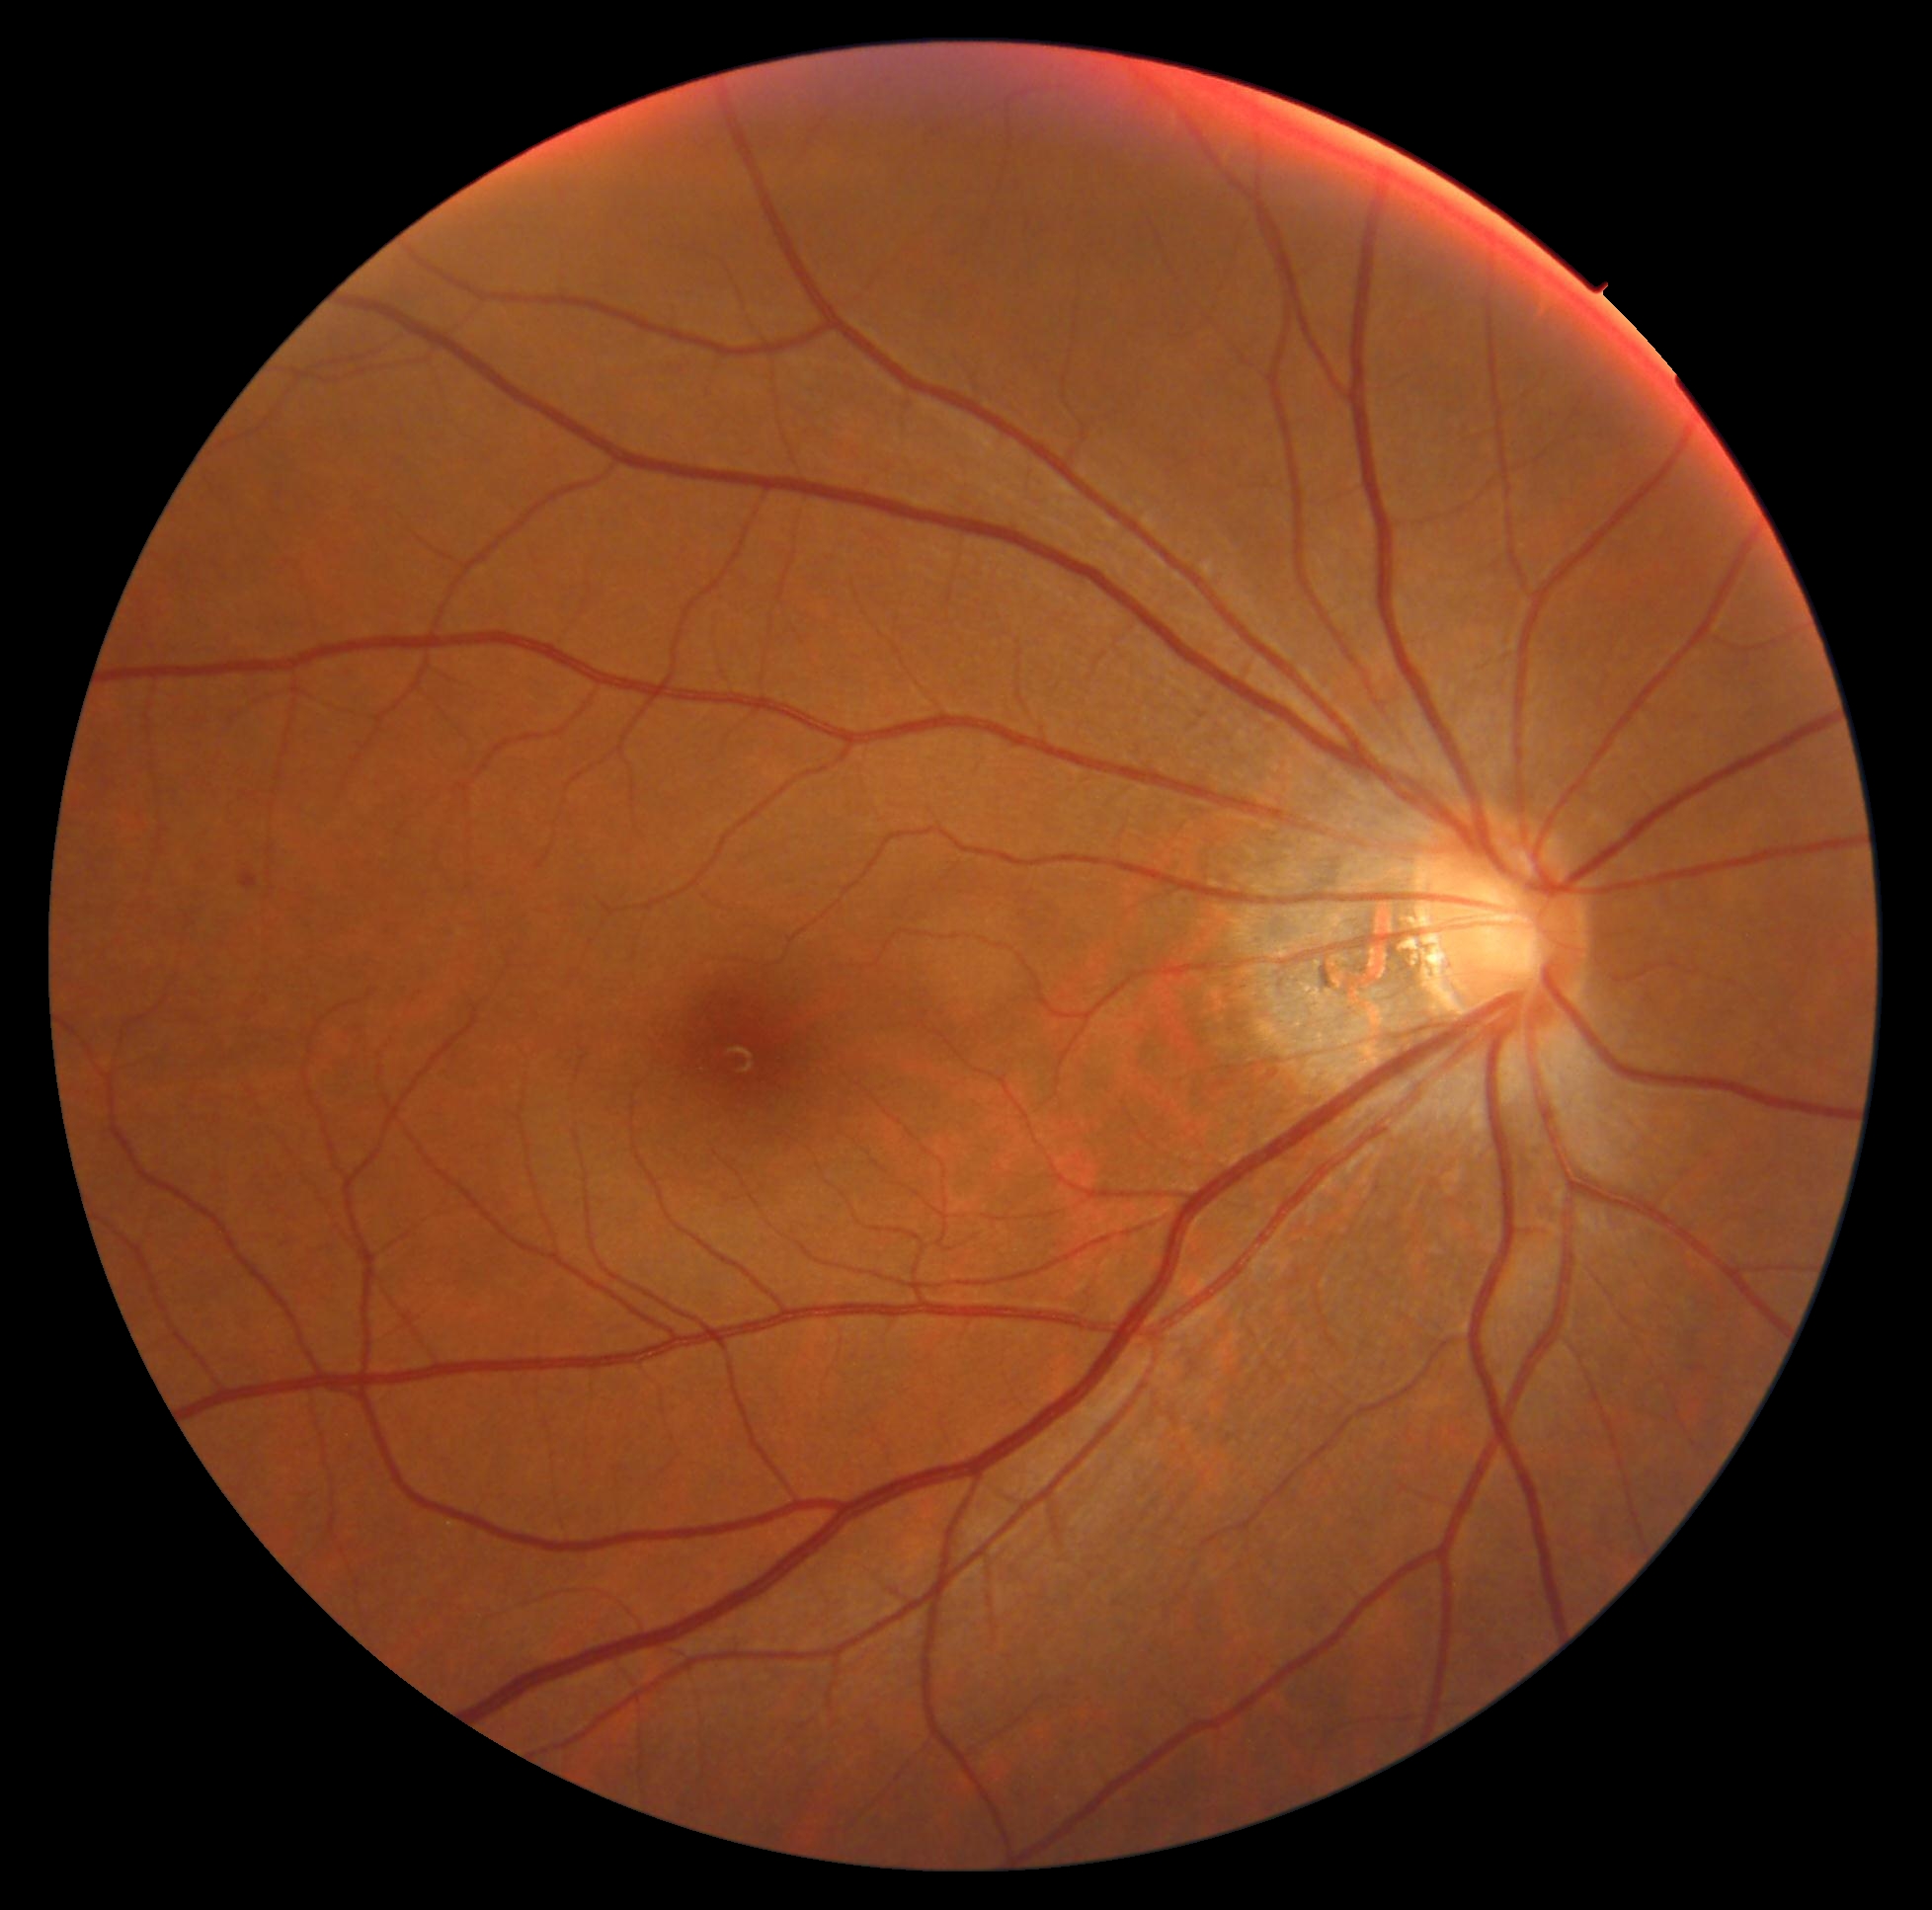 Diabetic retinopathy is grade 2 (moderate NPDR).